45-degree field of view.
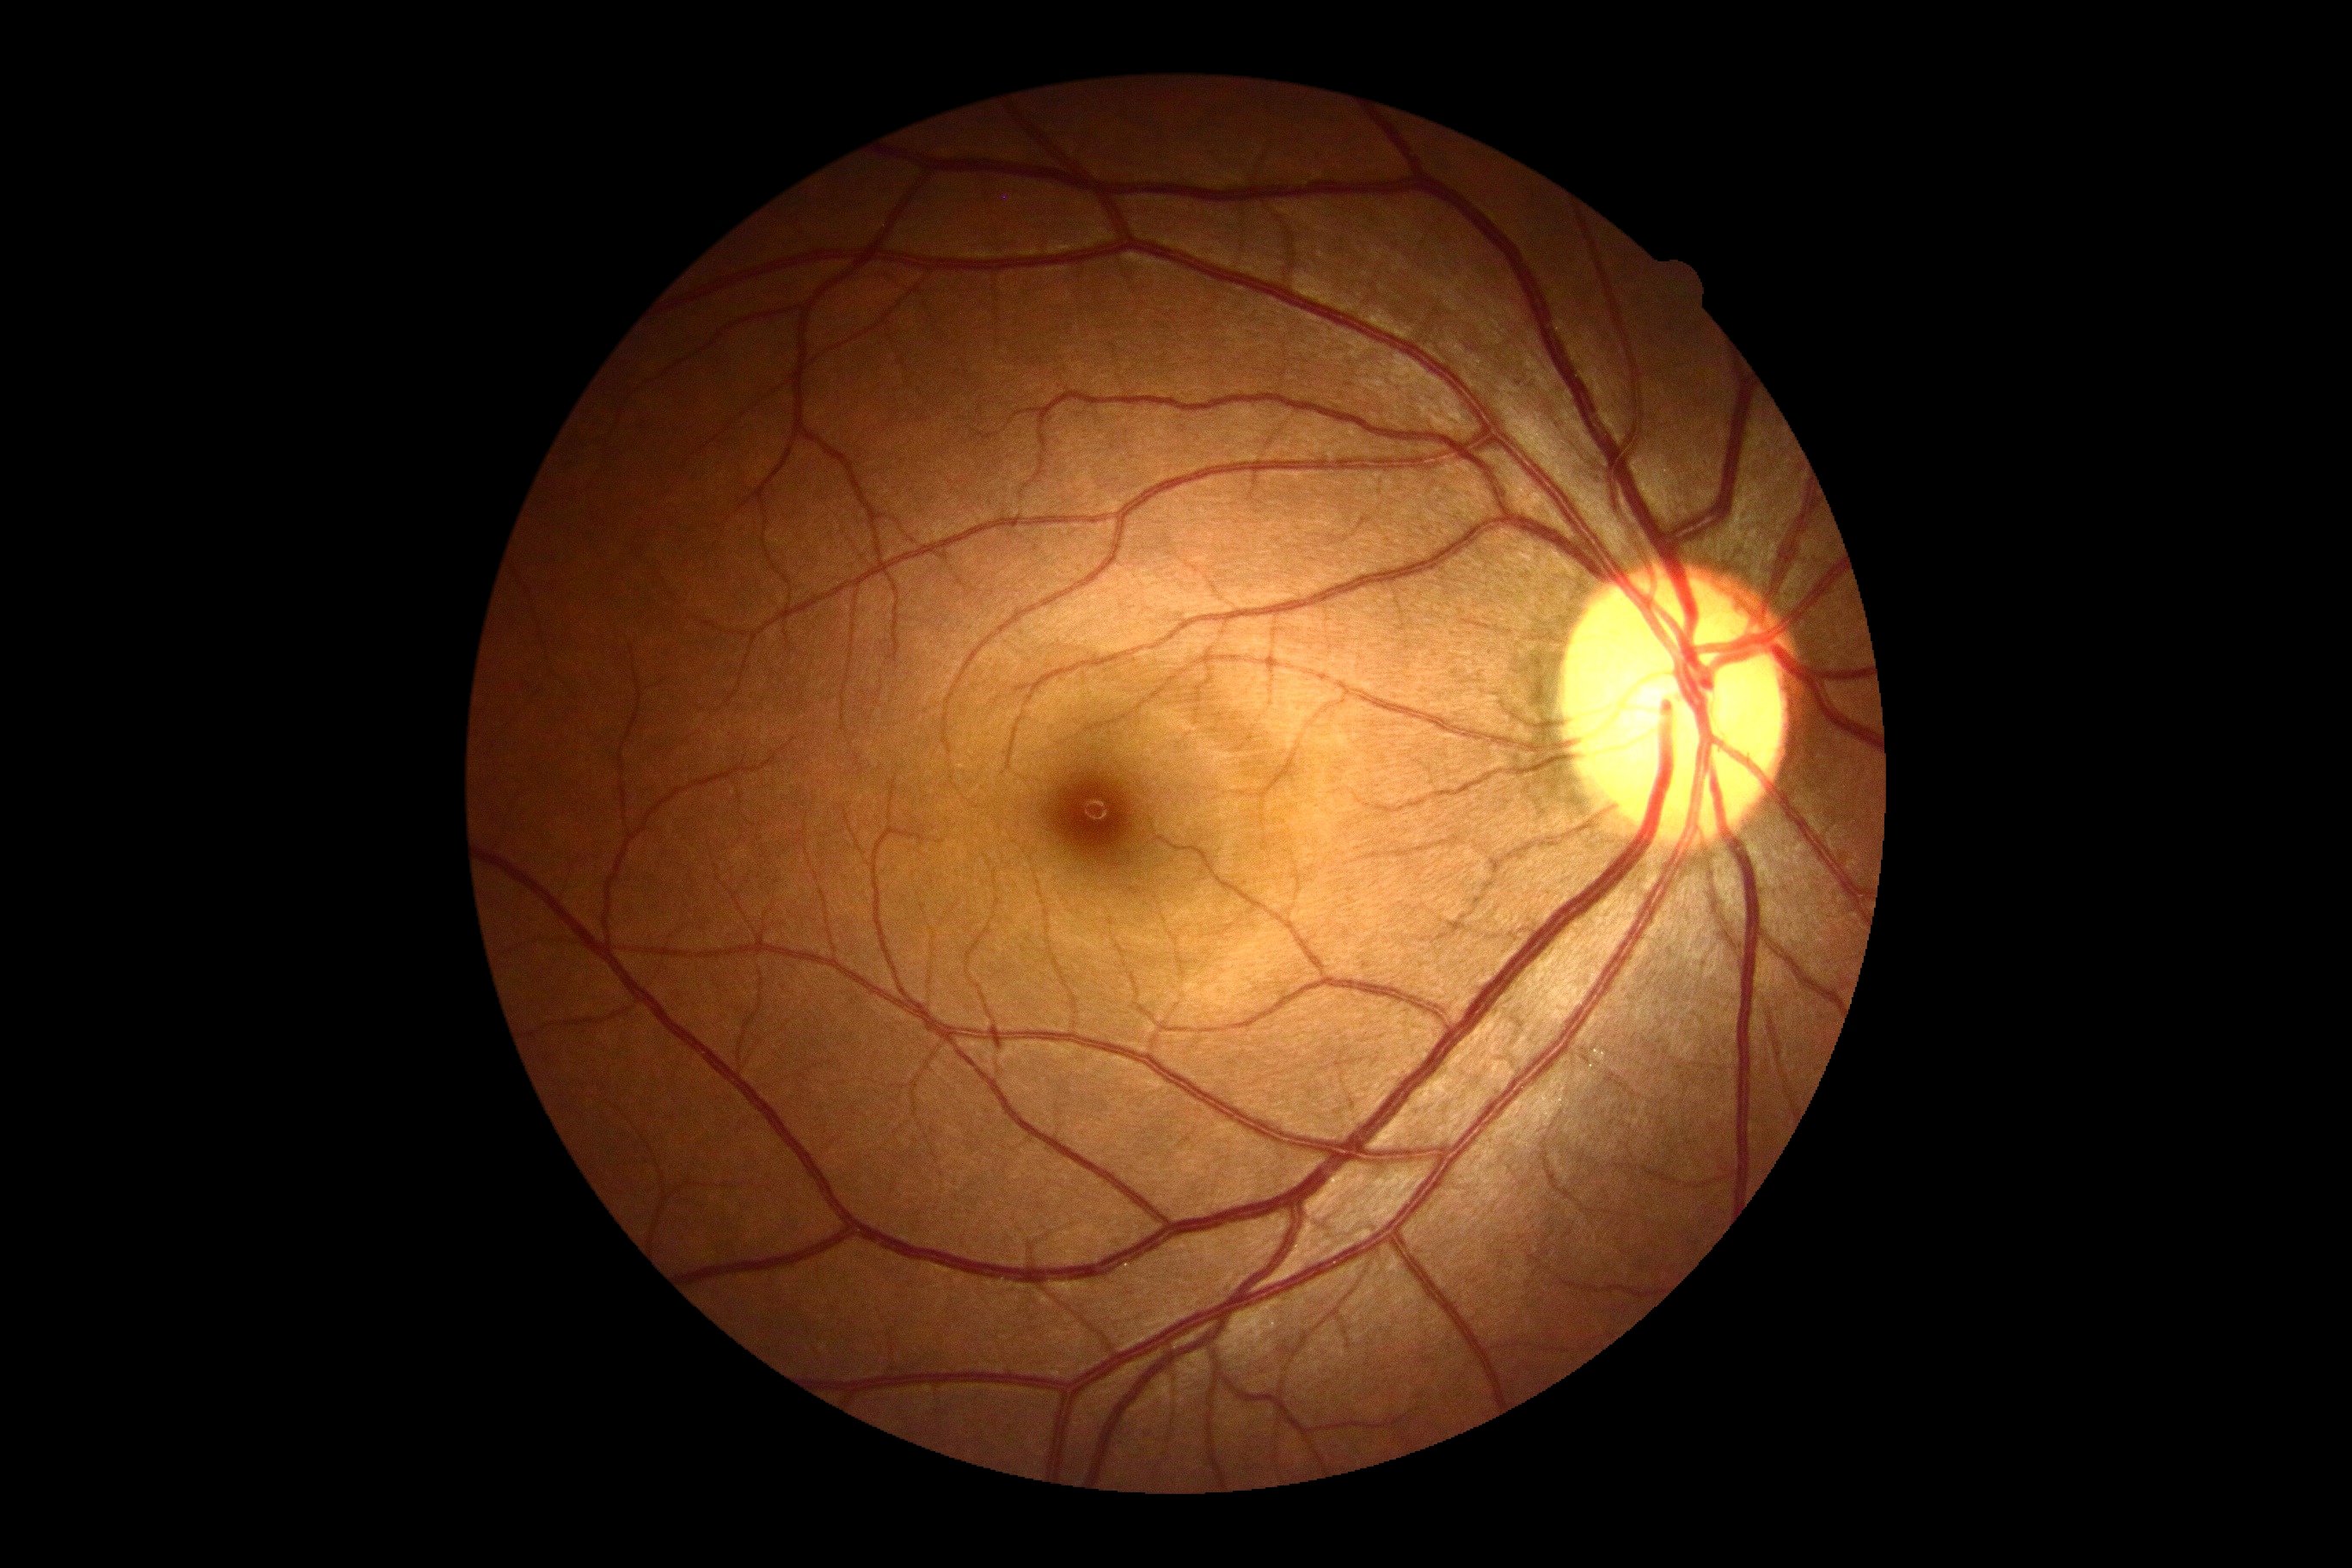
Diabetic retinopathy grade: 0/4.